Acquired on the Phoenix ICON · wide-field fundus image from infant ROP screening
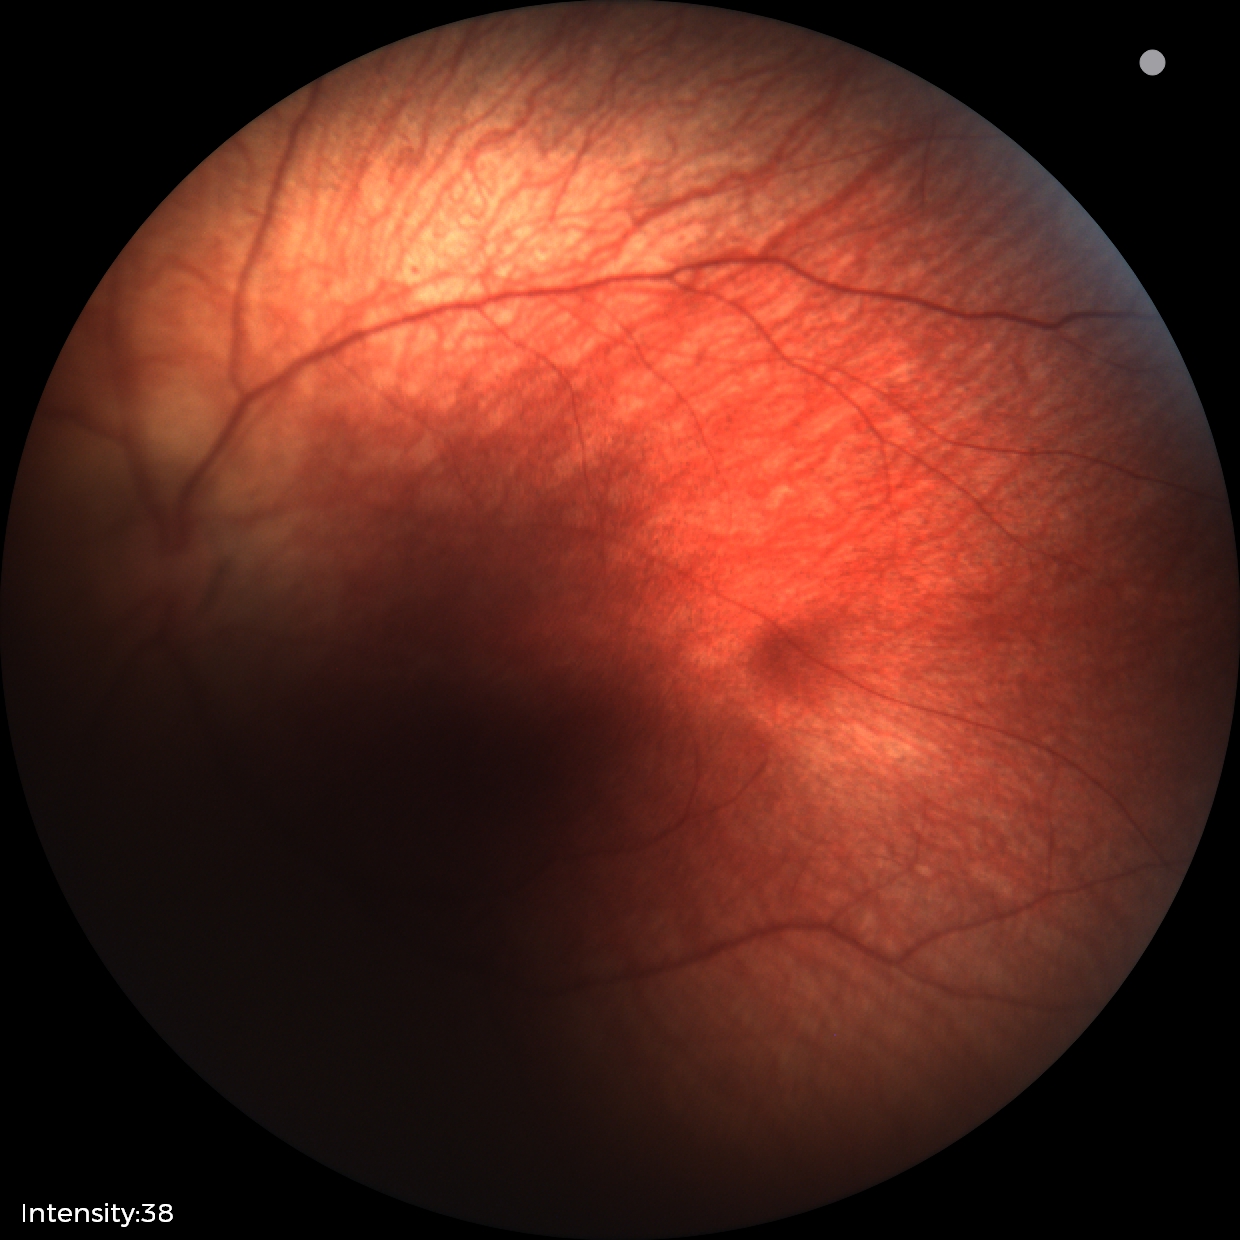 No retinal pathology identified on screening.